NIDEK AFC-230; graded on the modified Davis scale; 848 x 848 pixels — 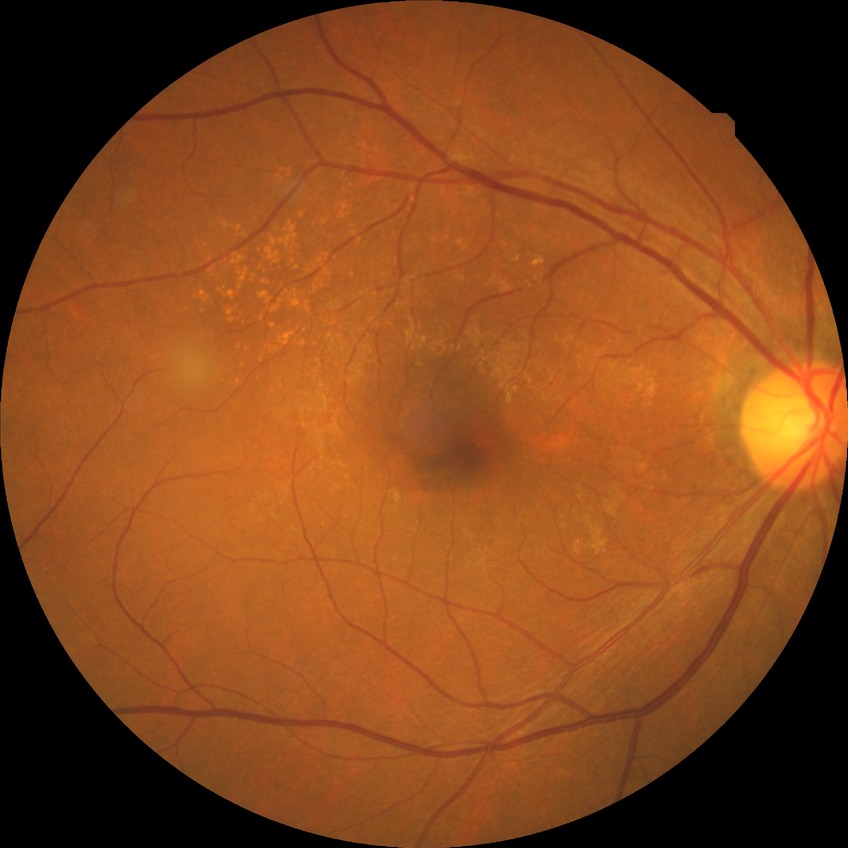
Assessment:
• diabetic retinopathy (DR): NDR (no diabetic retinopathy)